45-degree field of view: 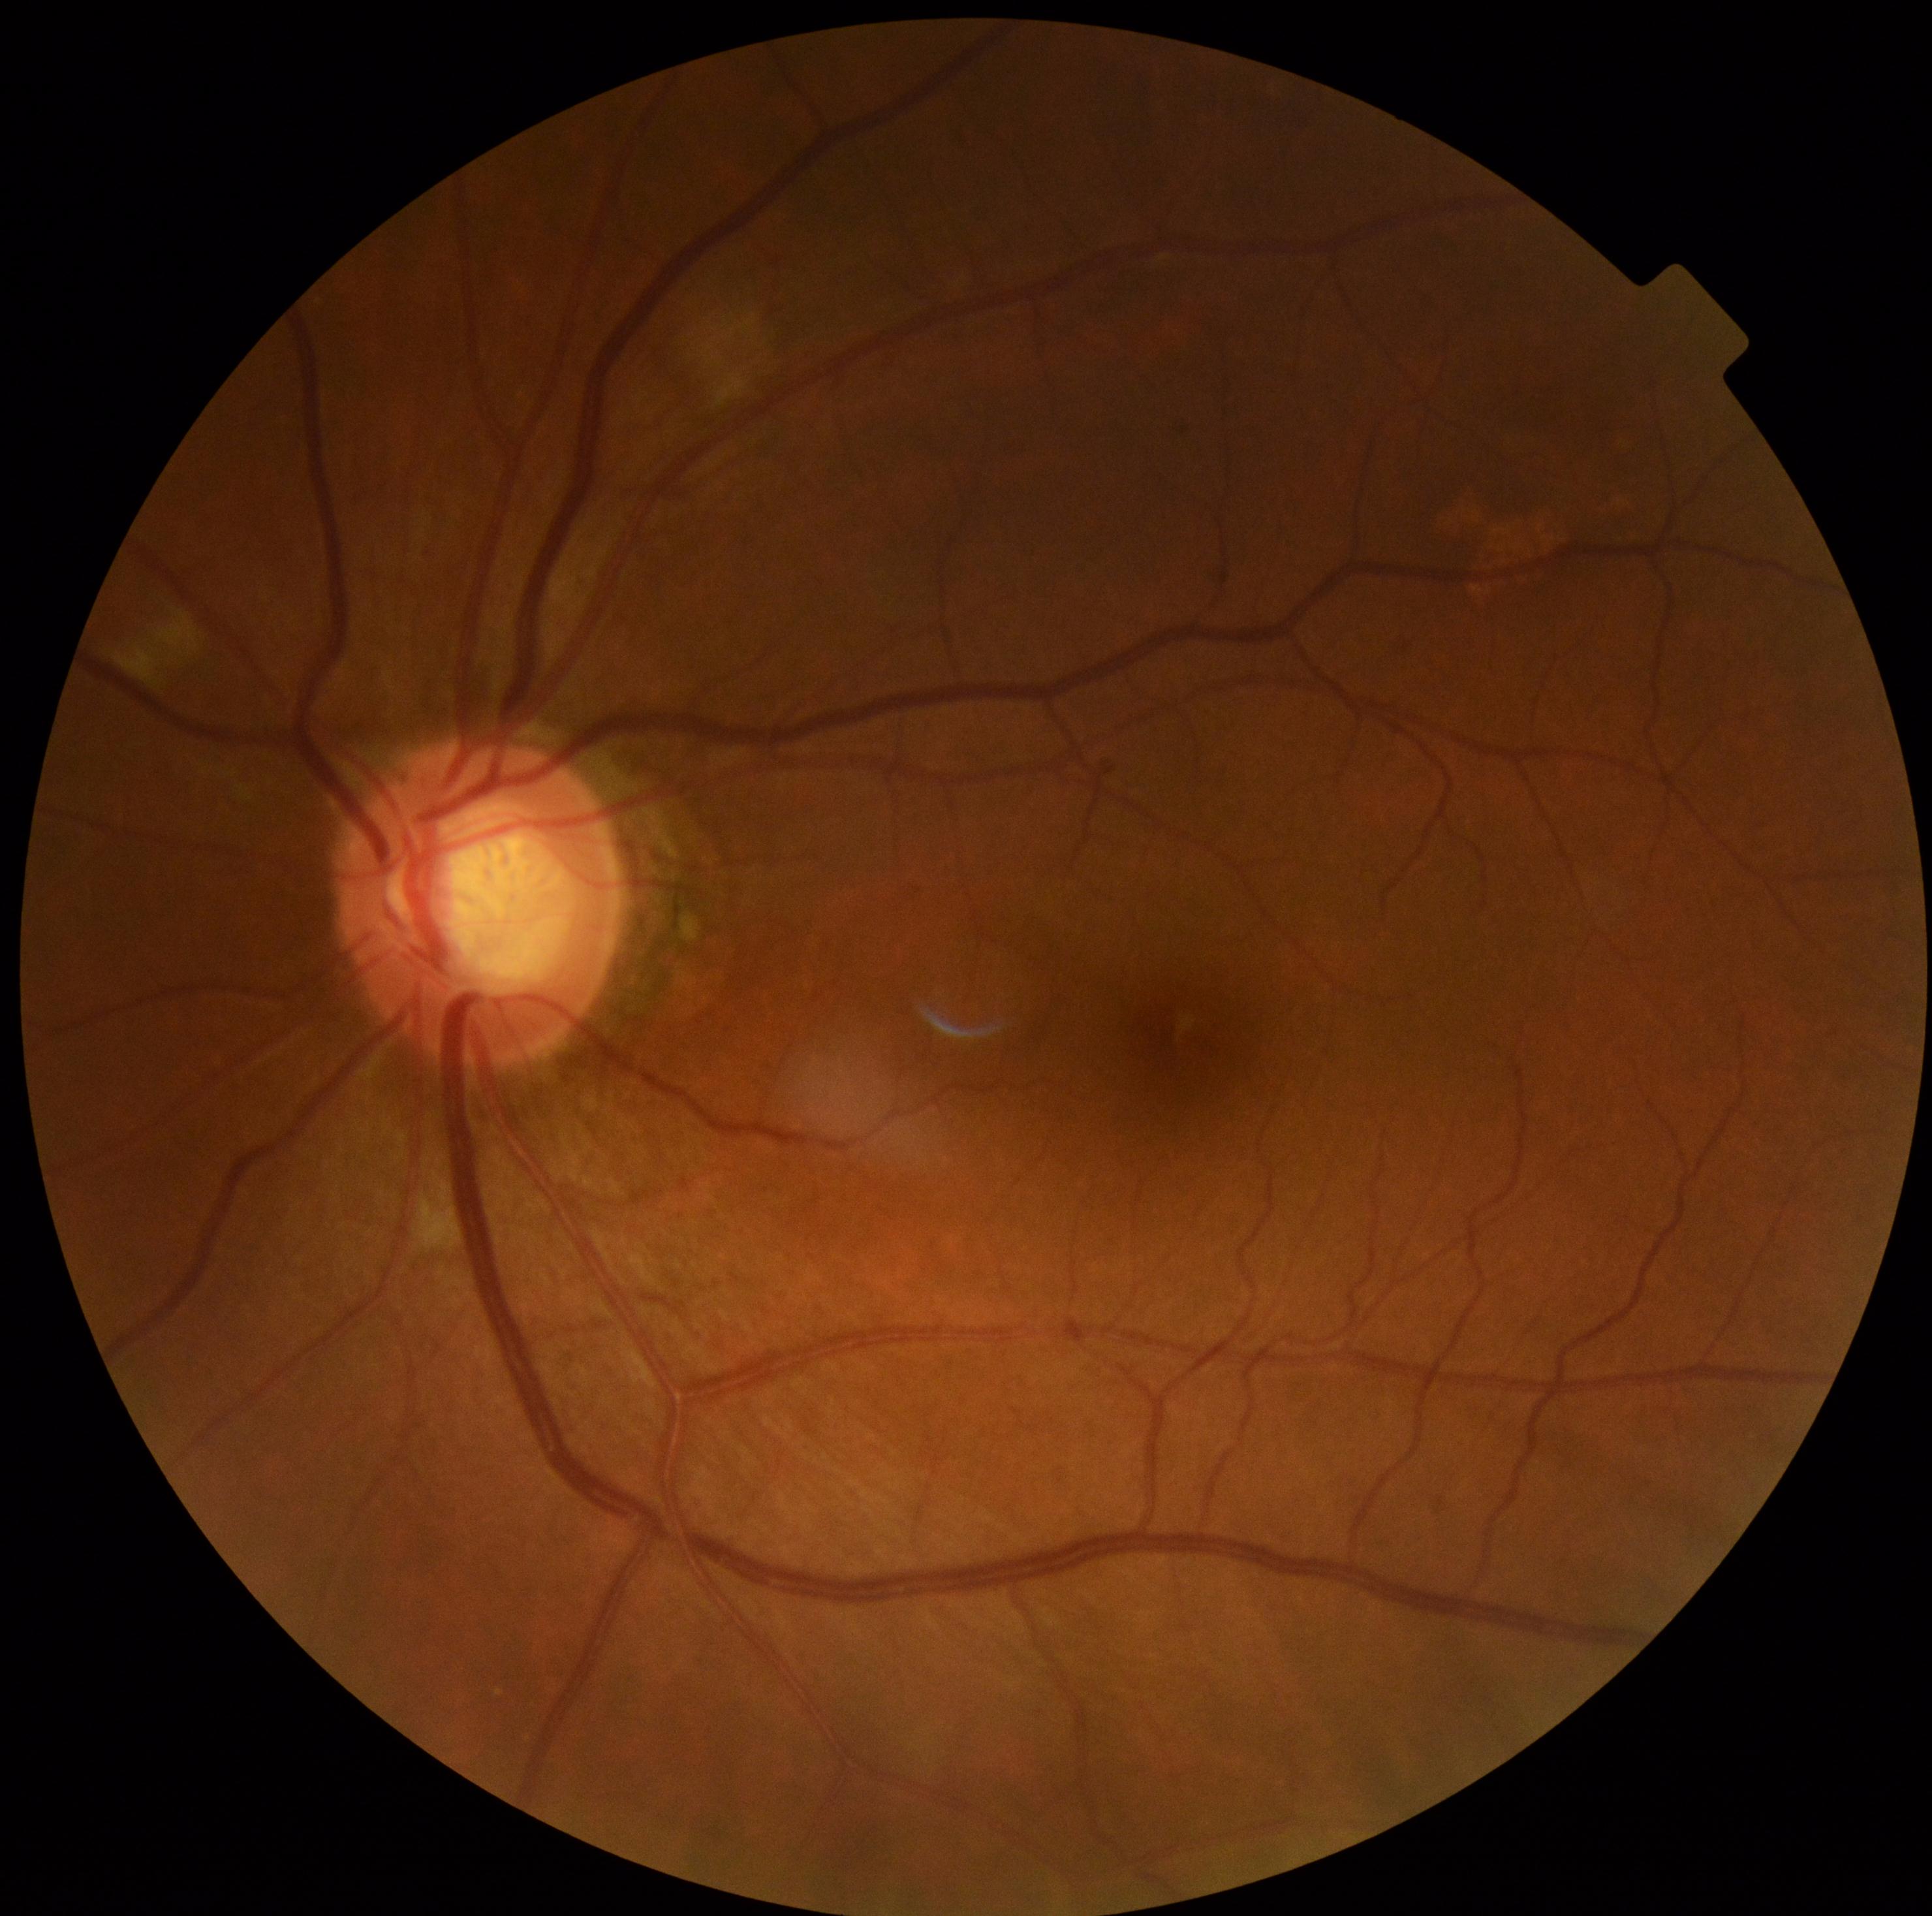
DR class: non-proliferative diabetic retinopathy. Diabetic retinopathy severity: 2/4.